NIDEK AFC-230 — 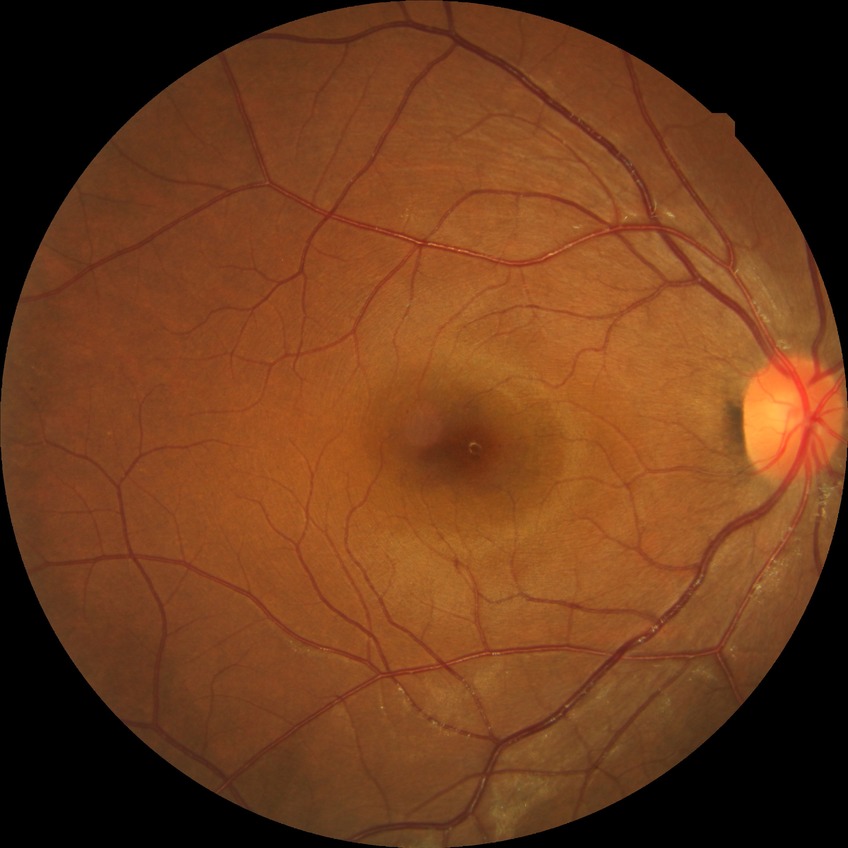 modified Davis classification: no diabetic retinopathy.